Image size 1534x1534; 50° field of view; retinal fundus photograph:
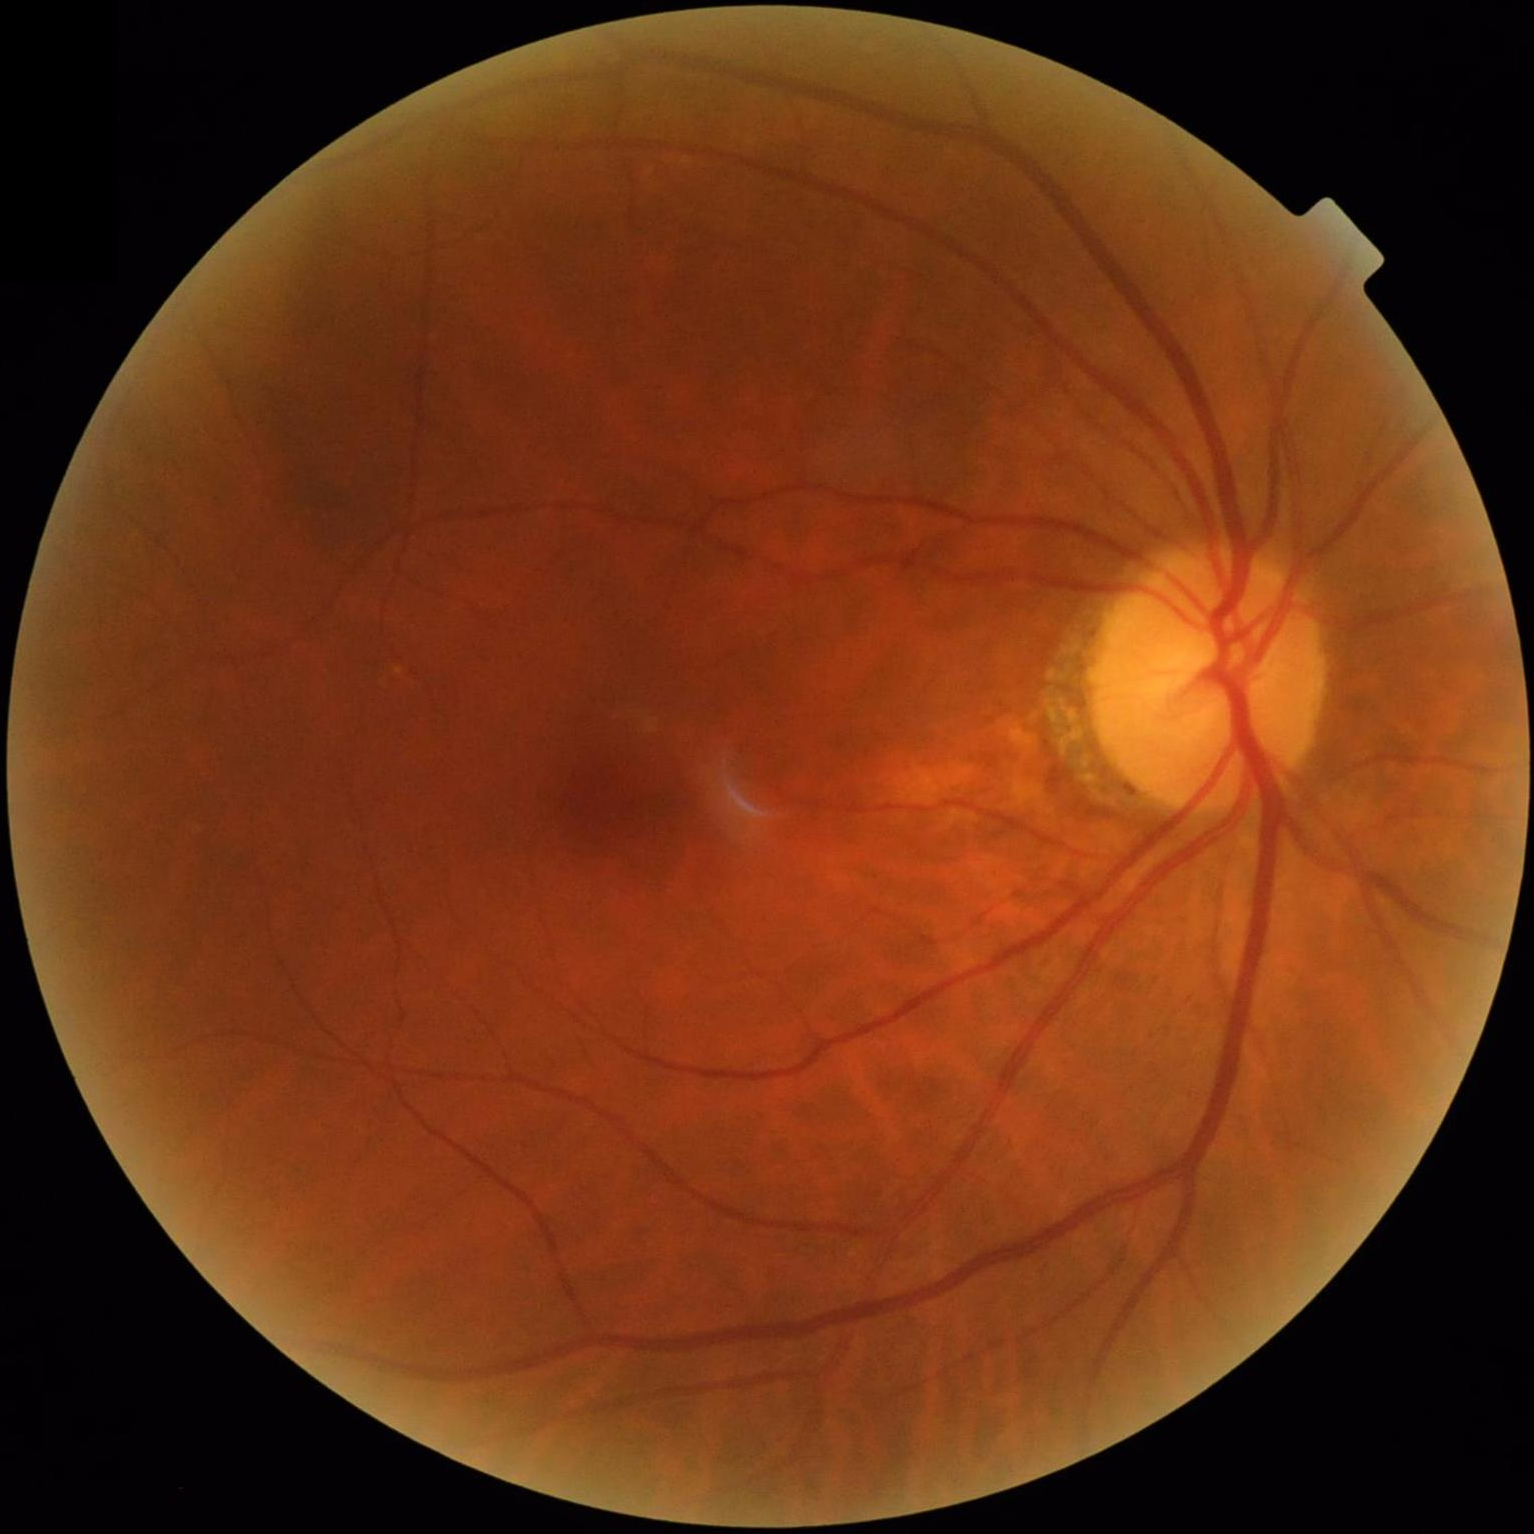 Vessels and details are readily distinguishable. Overall image quality is good.